2228x1652px. Captured after pupil dilation. Topcon TRC-50DX. Posterior pole view:
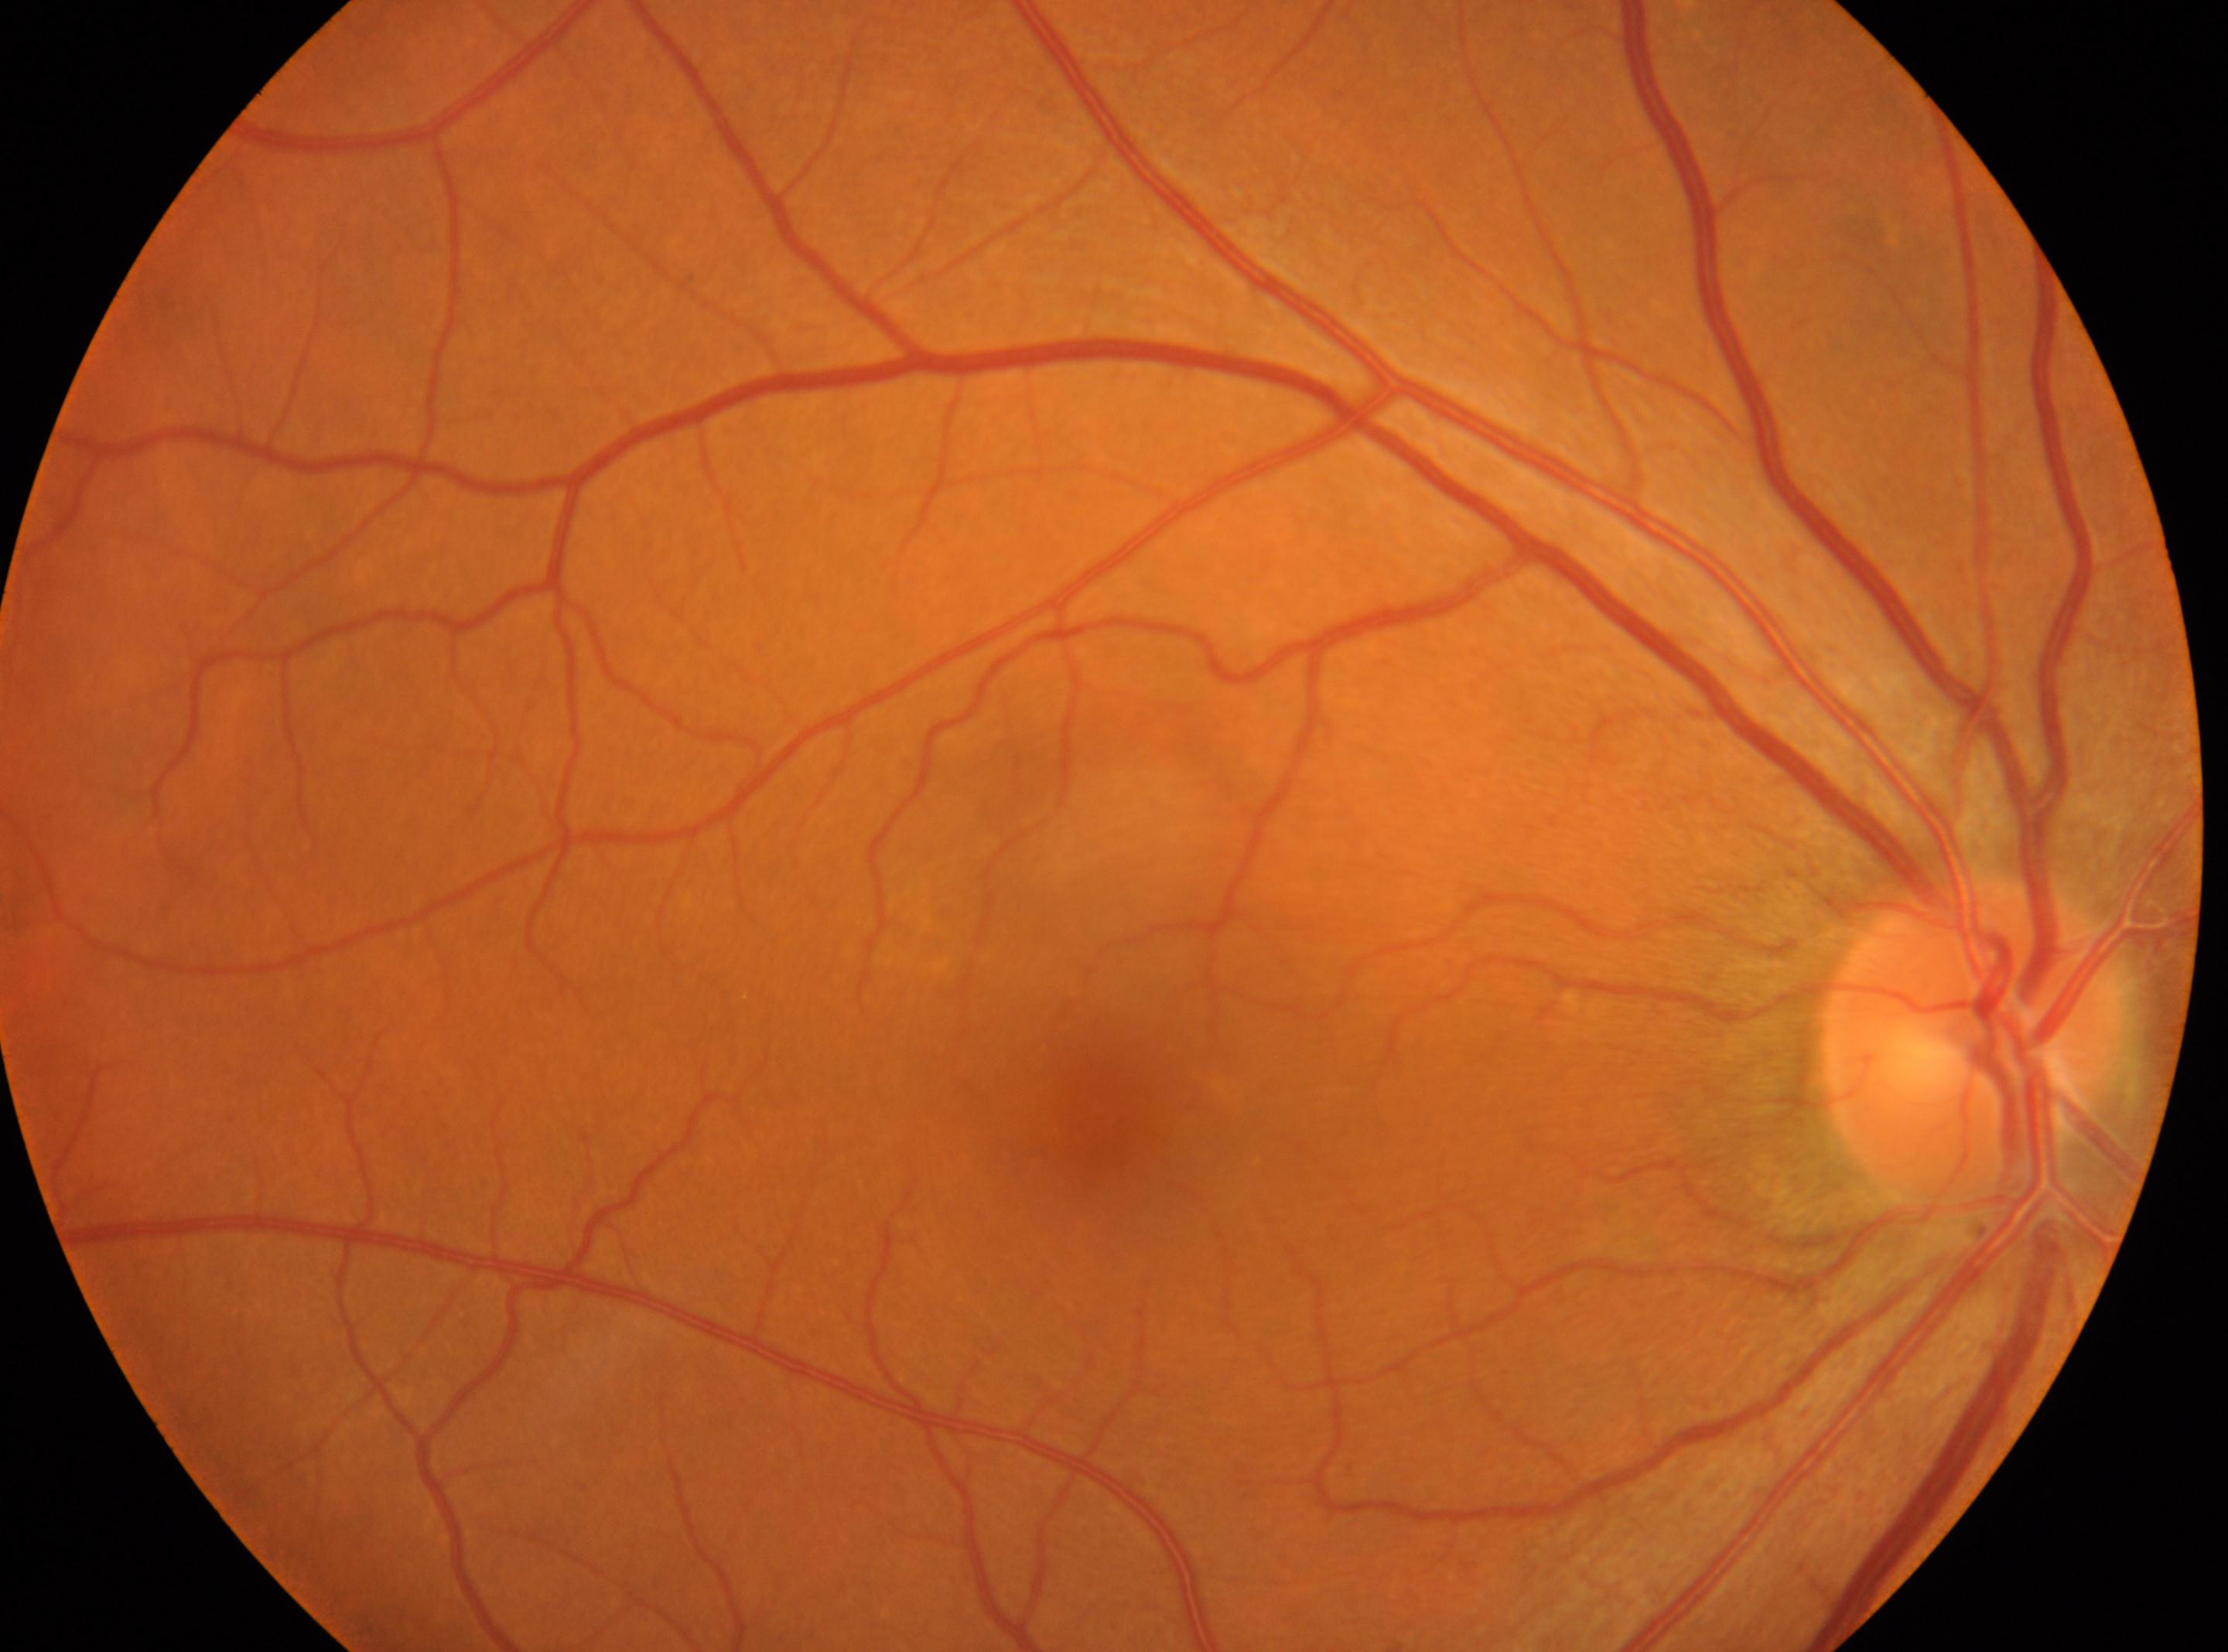 optic nerve head = (x: 1974, y: 1043)
DR severity = 0
macula center = (x: 1078, y: 1126)
DR impression = No diabetic retinal disease findings
laterality = the right eye